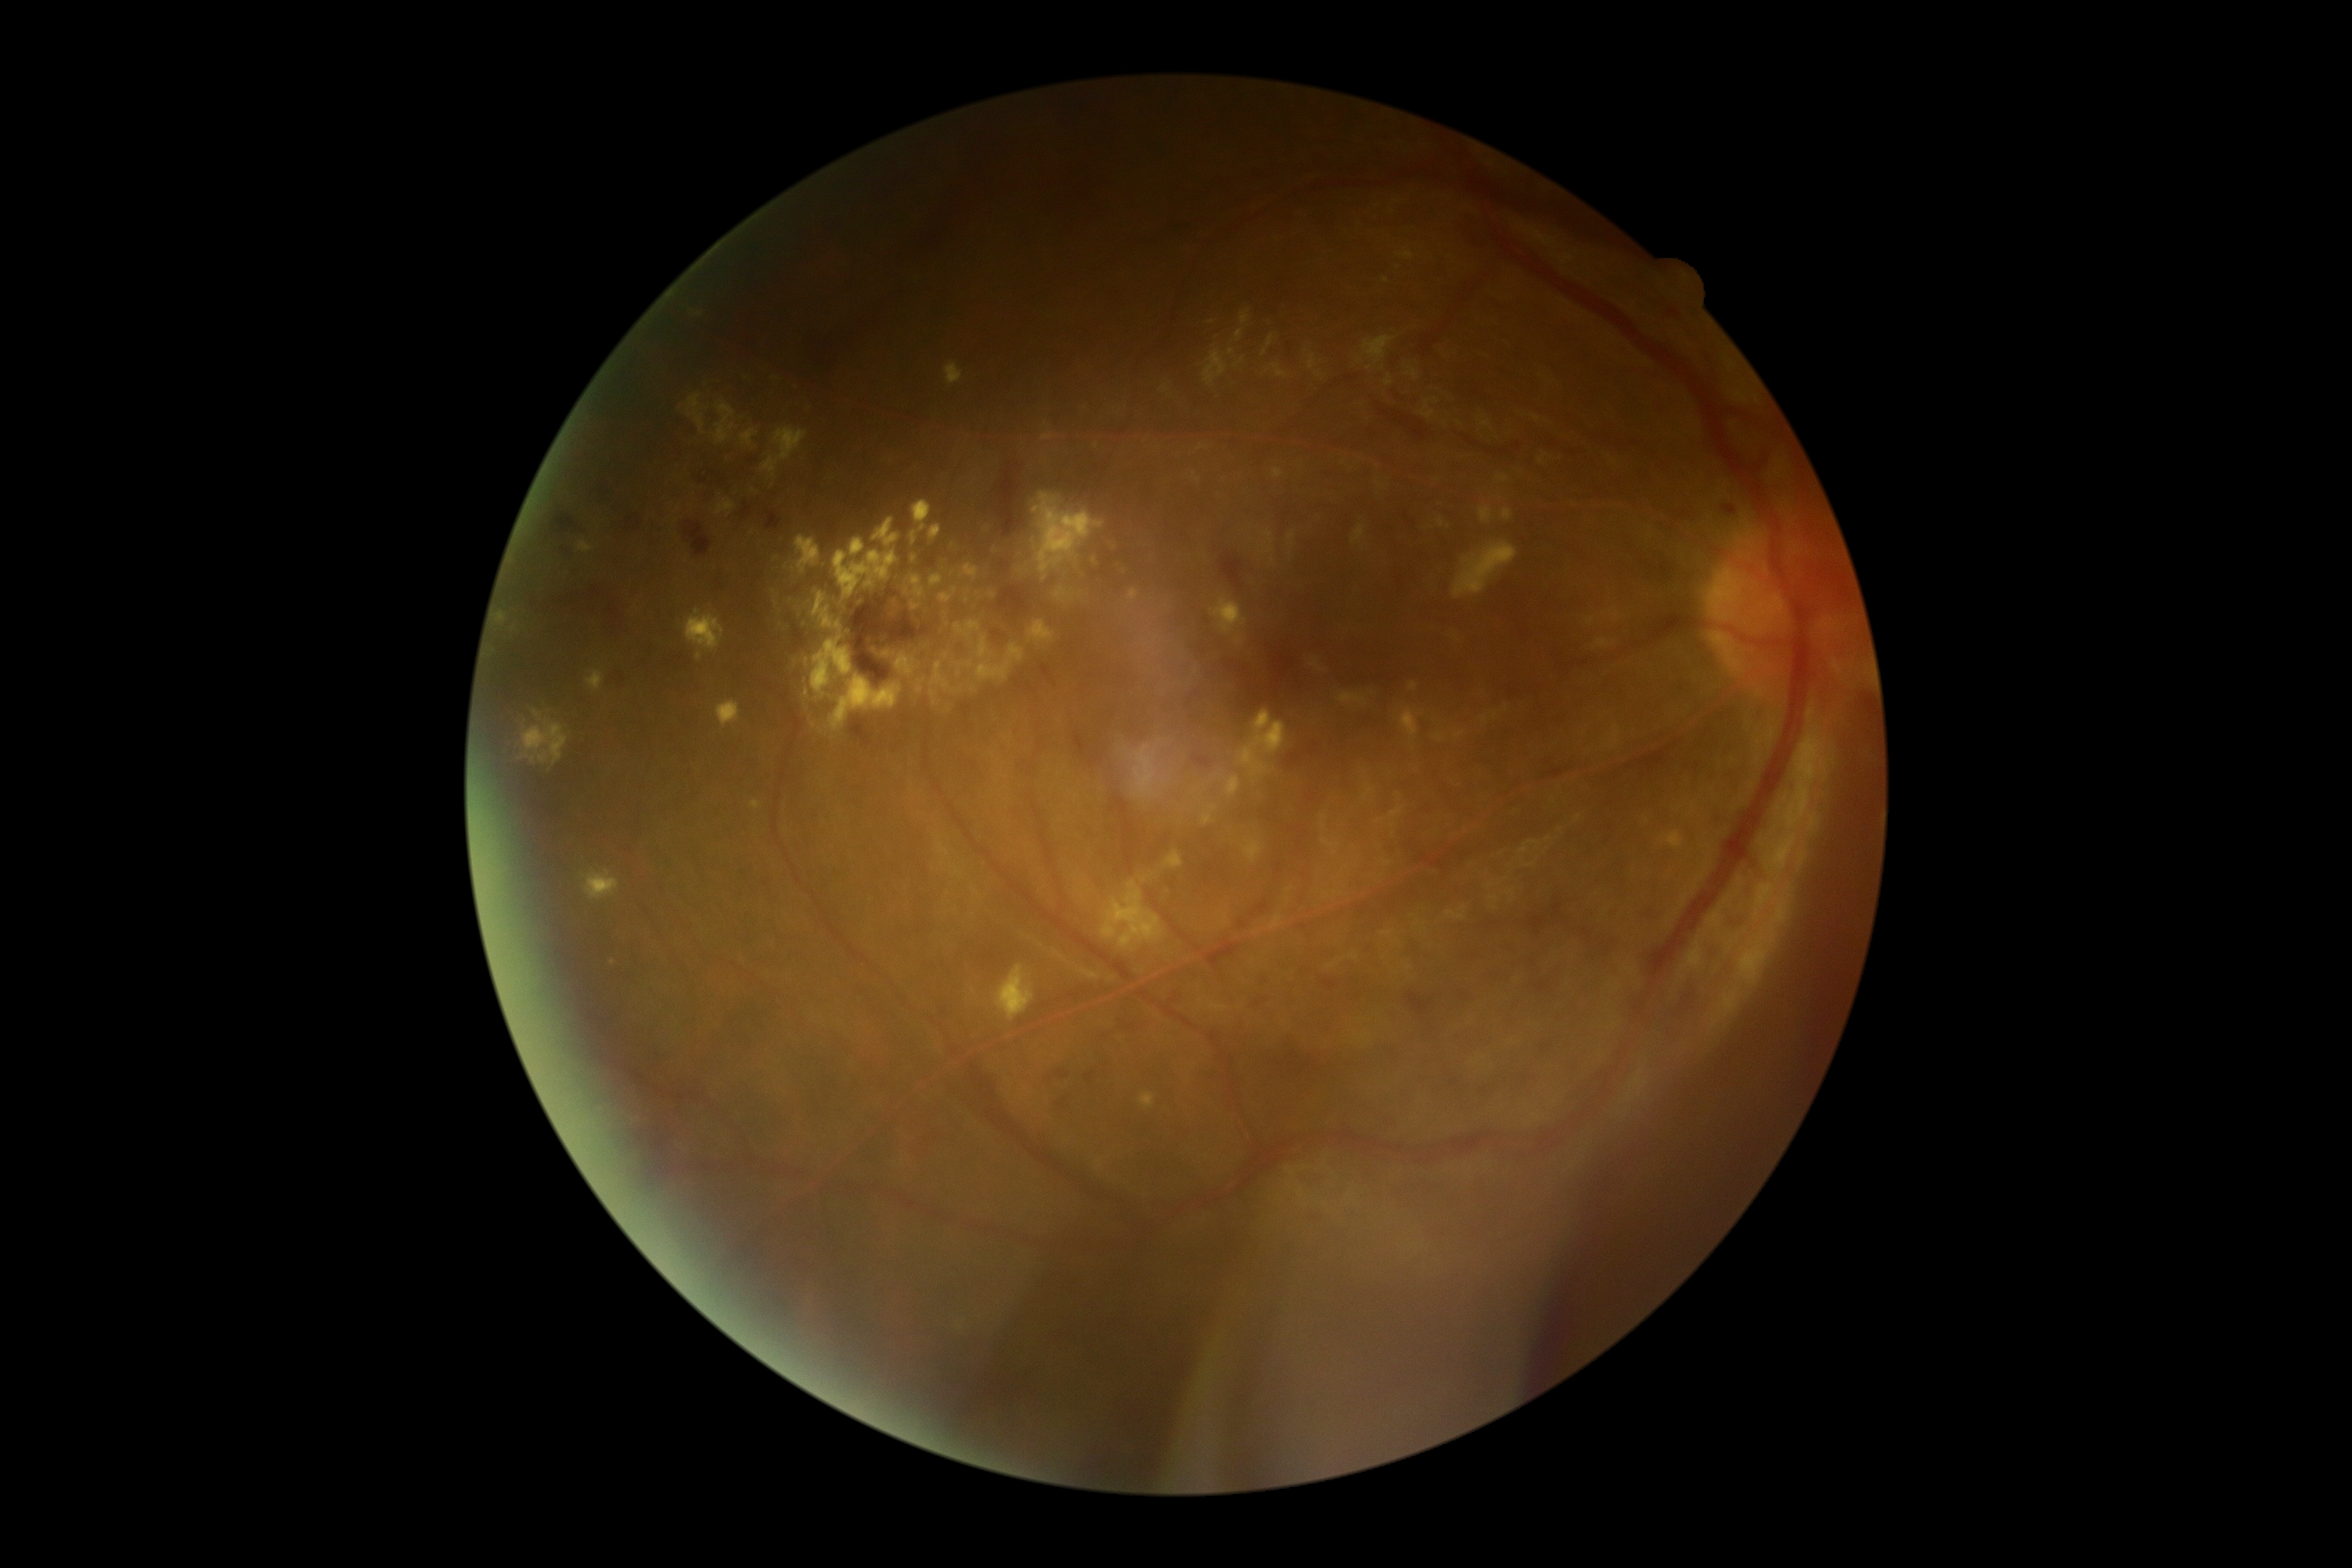
Retinopathy: grade 2 (moderate NPDR).